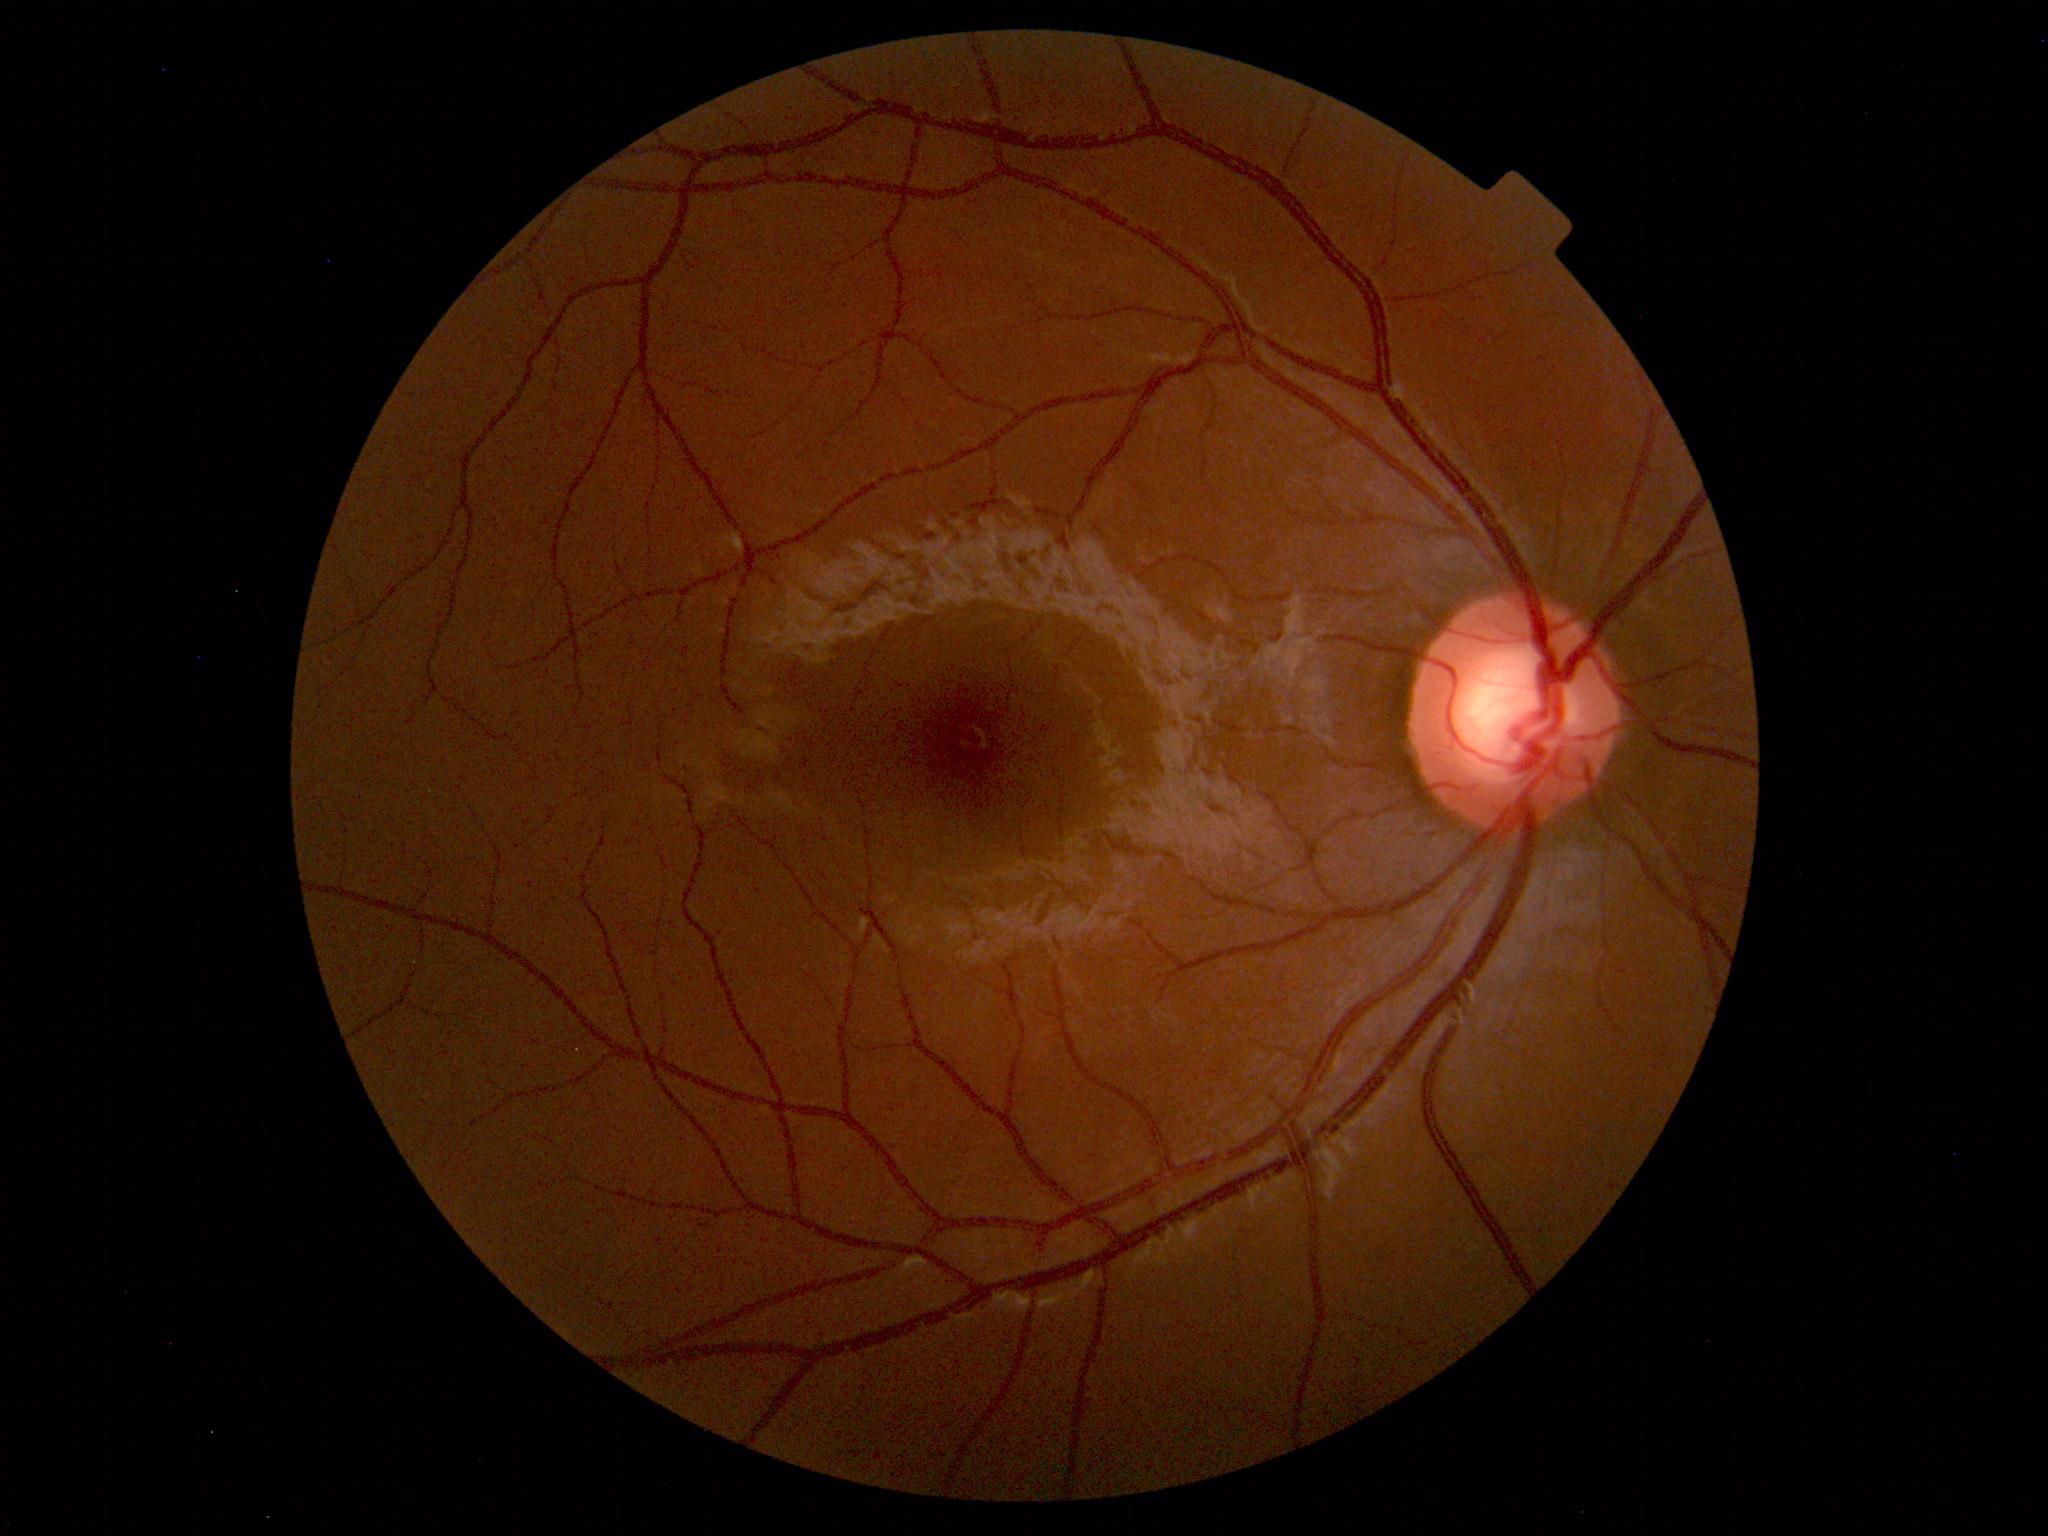

Impression: within normal limits.